45° field of view; acquired with a NIDEK AFC-230; posterior pole photograph; no pharmacologic dilation
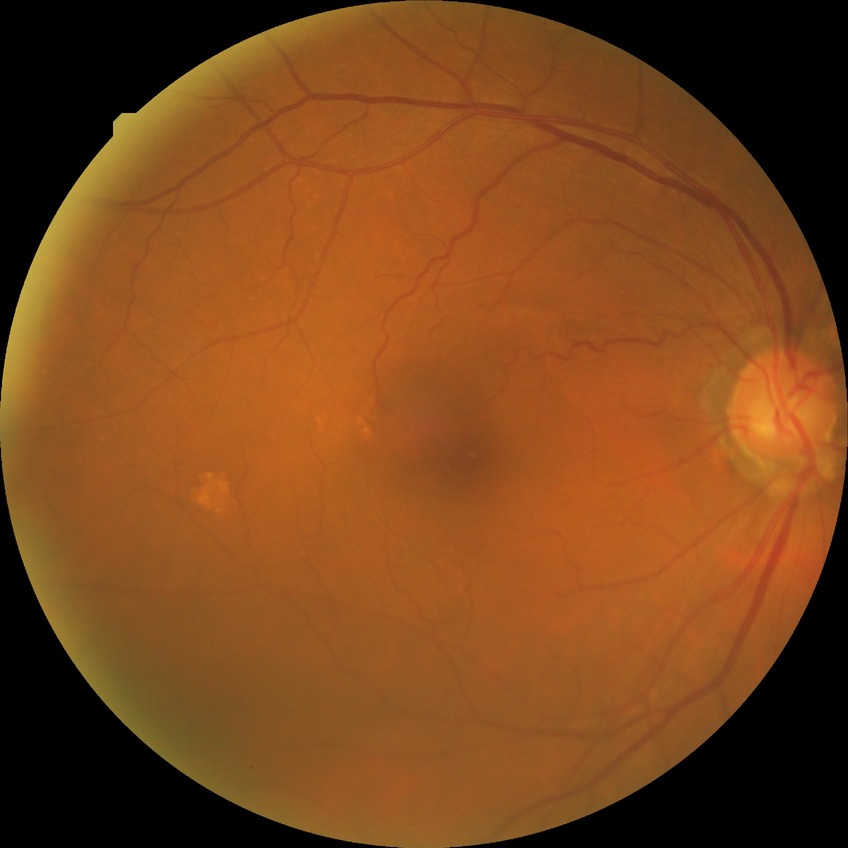

Davis stage = NDR.